CFP, without pupil dilation, 848x848: 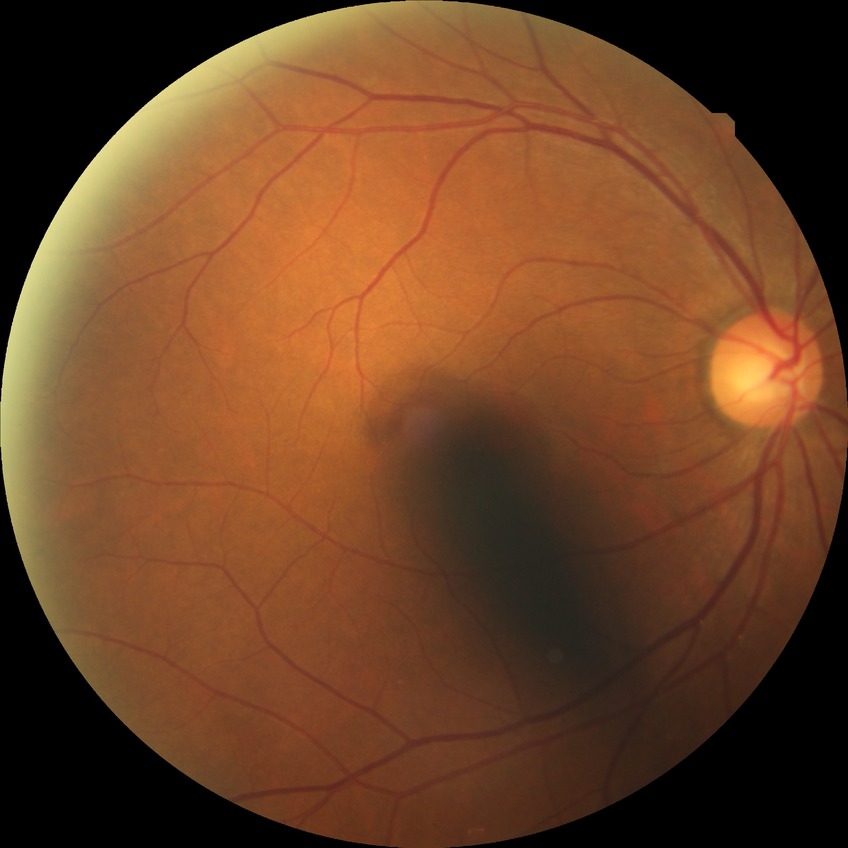
diabetic retinopathy (DR): no diabetic retinopathy (NDR).